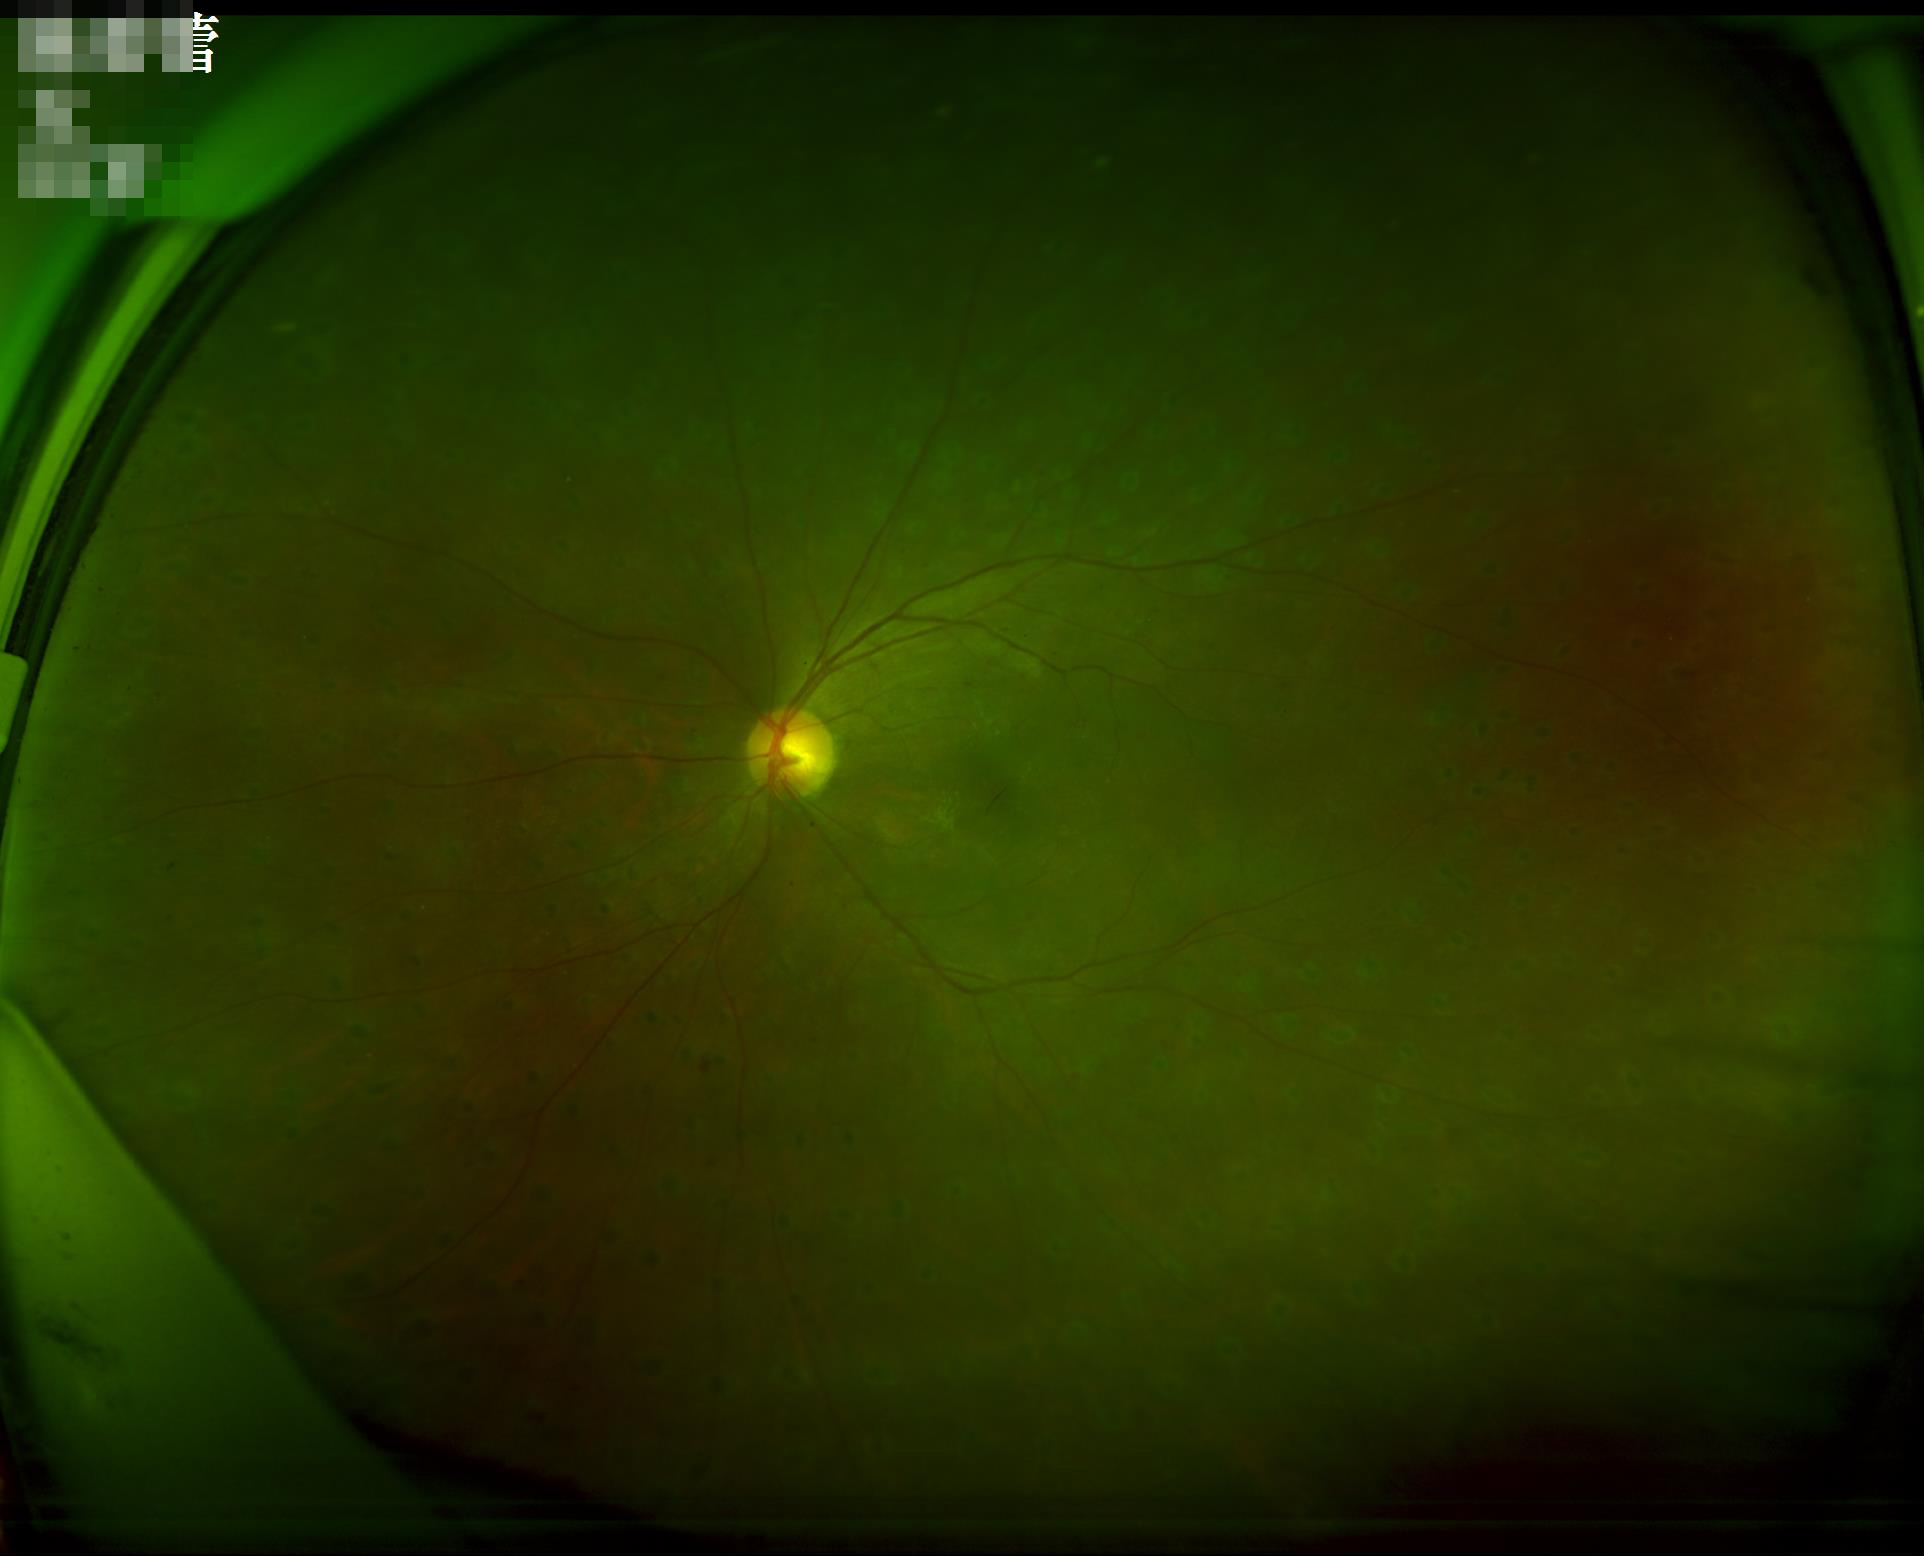 Illumination and color balance are good.
Overall quality is good and the image is gradable.
Contrast is good.
Optic disc, vessels, and background are in focus.